Pediatric retinal photograph (wide-field):
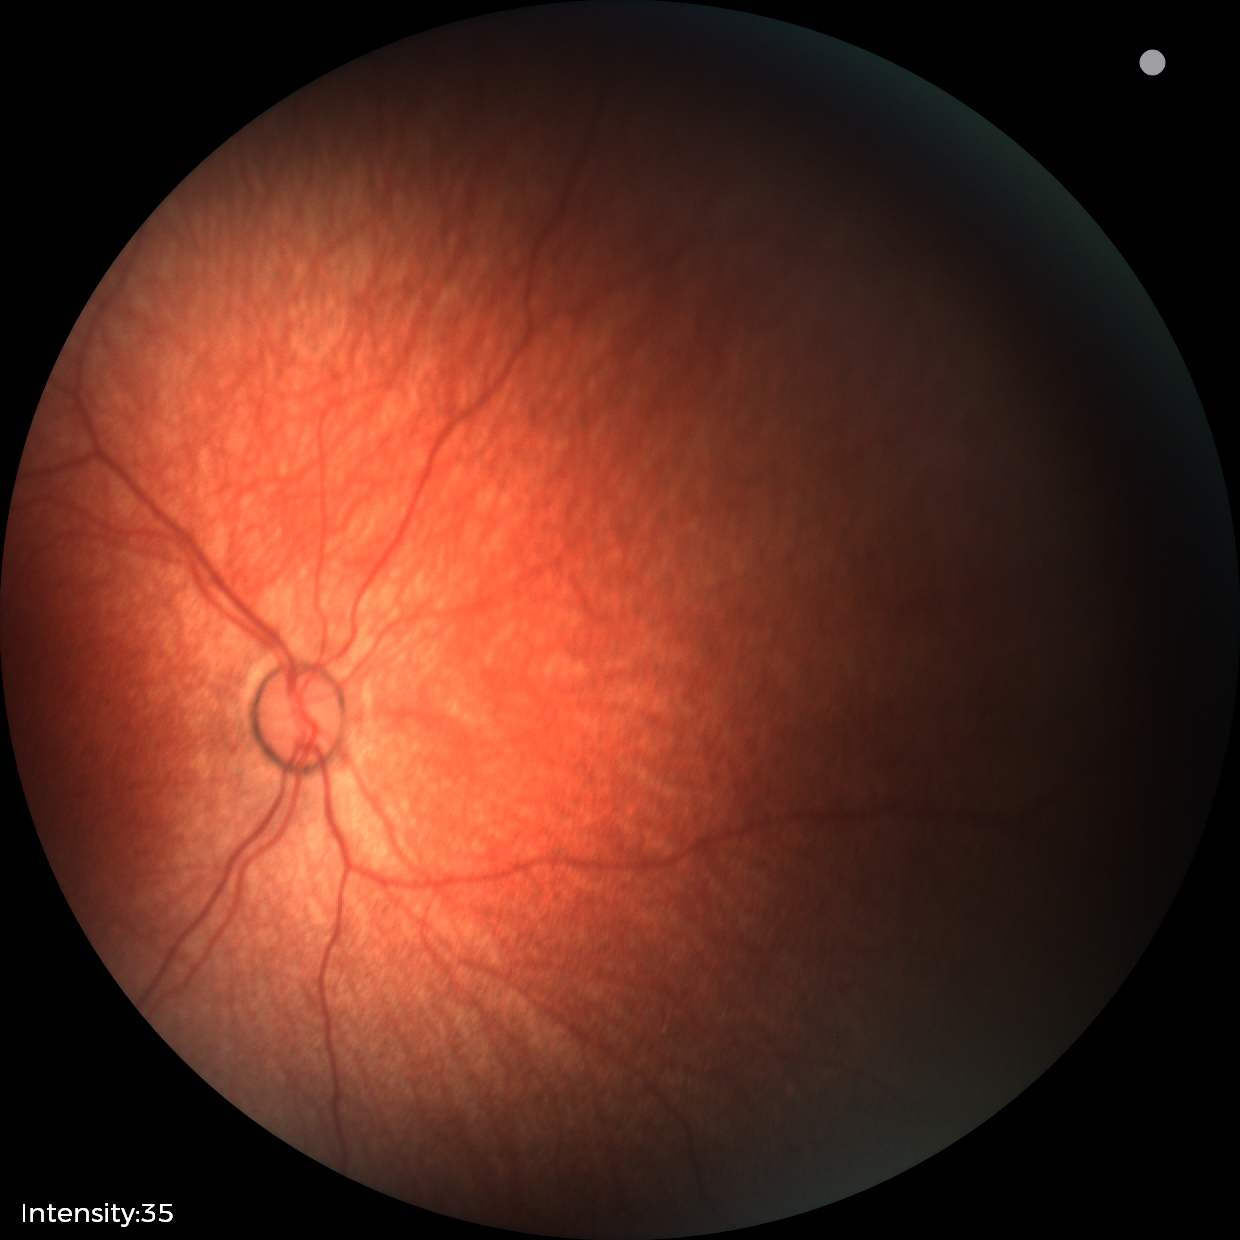

Physiological retinal appearance for postconceptual age.